Color fundus photograph, 1659 x 2212 pixels, captured on a Remidio Fundus on Phone (FOP) camera.
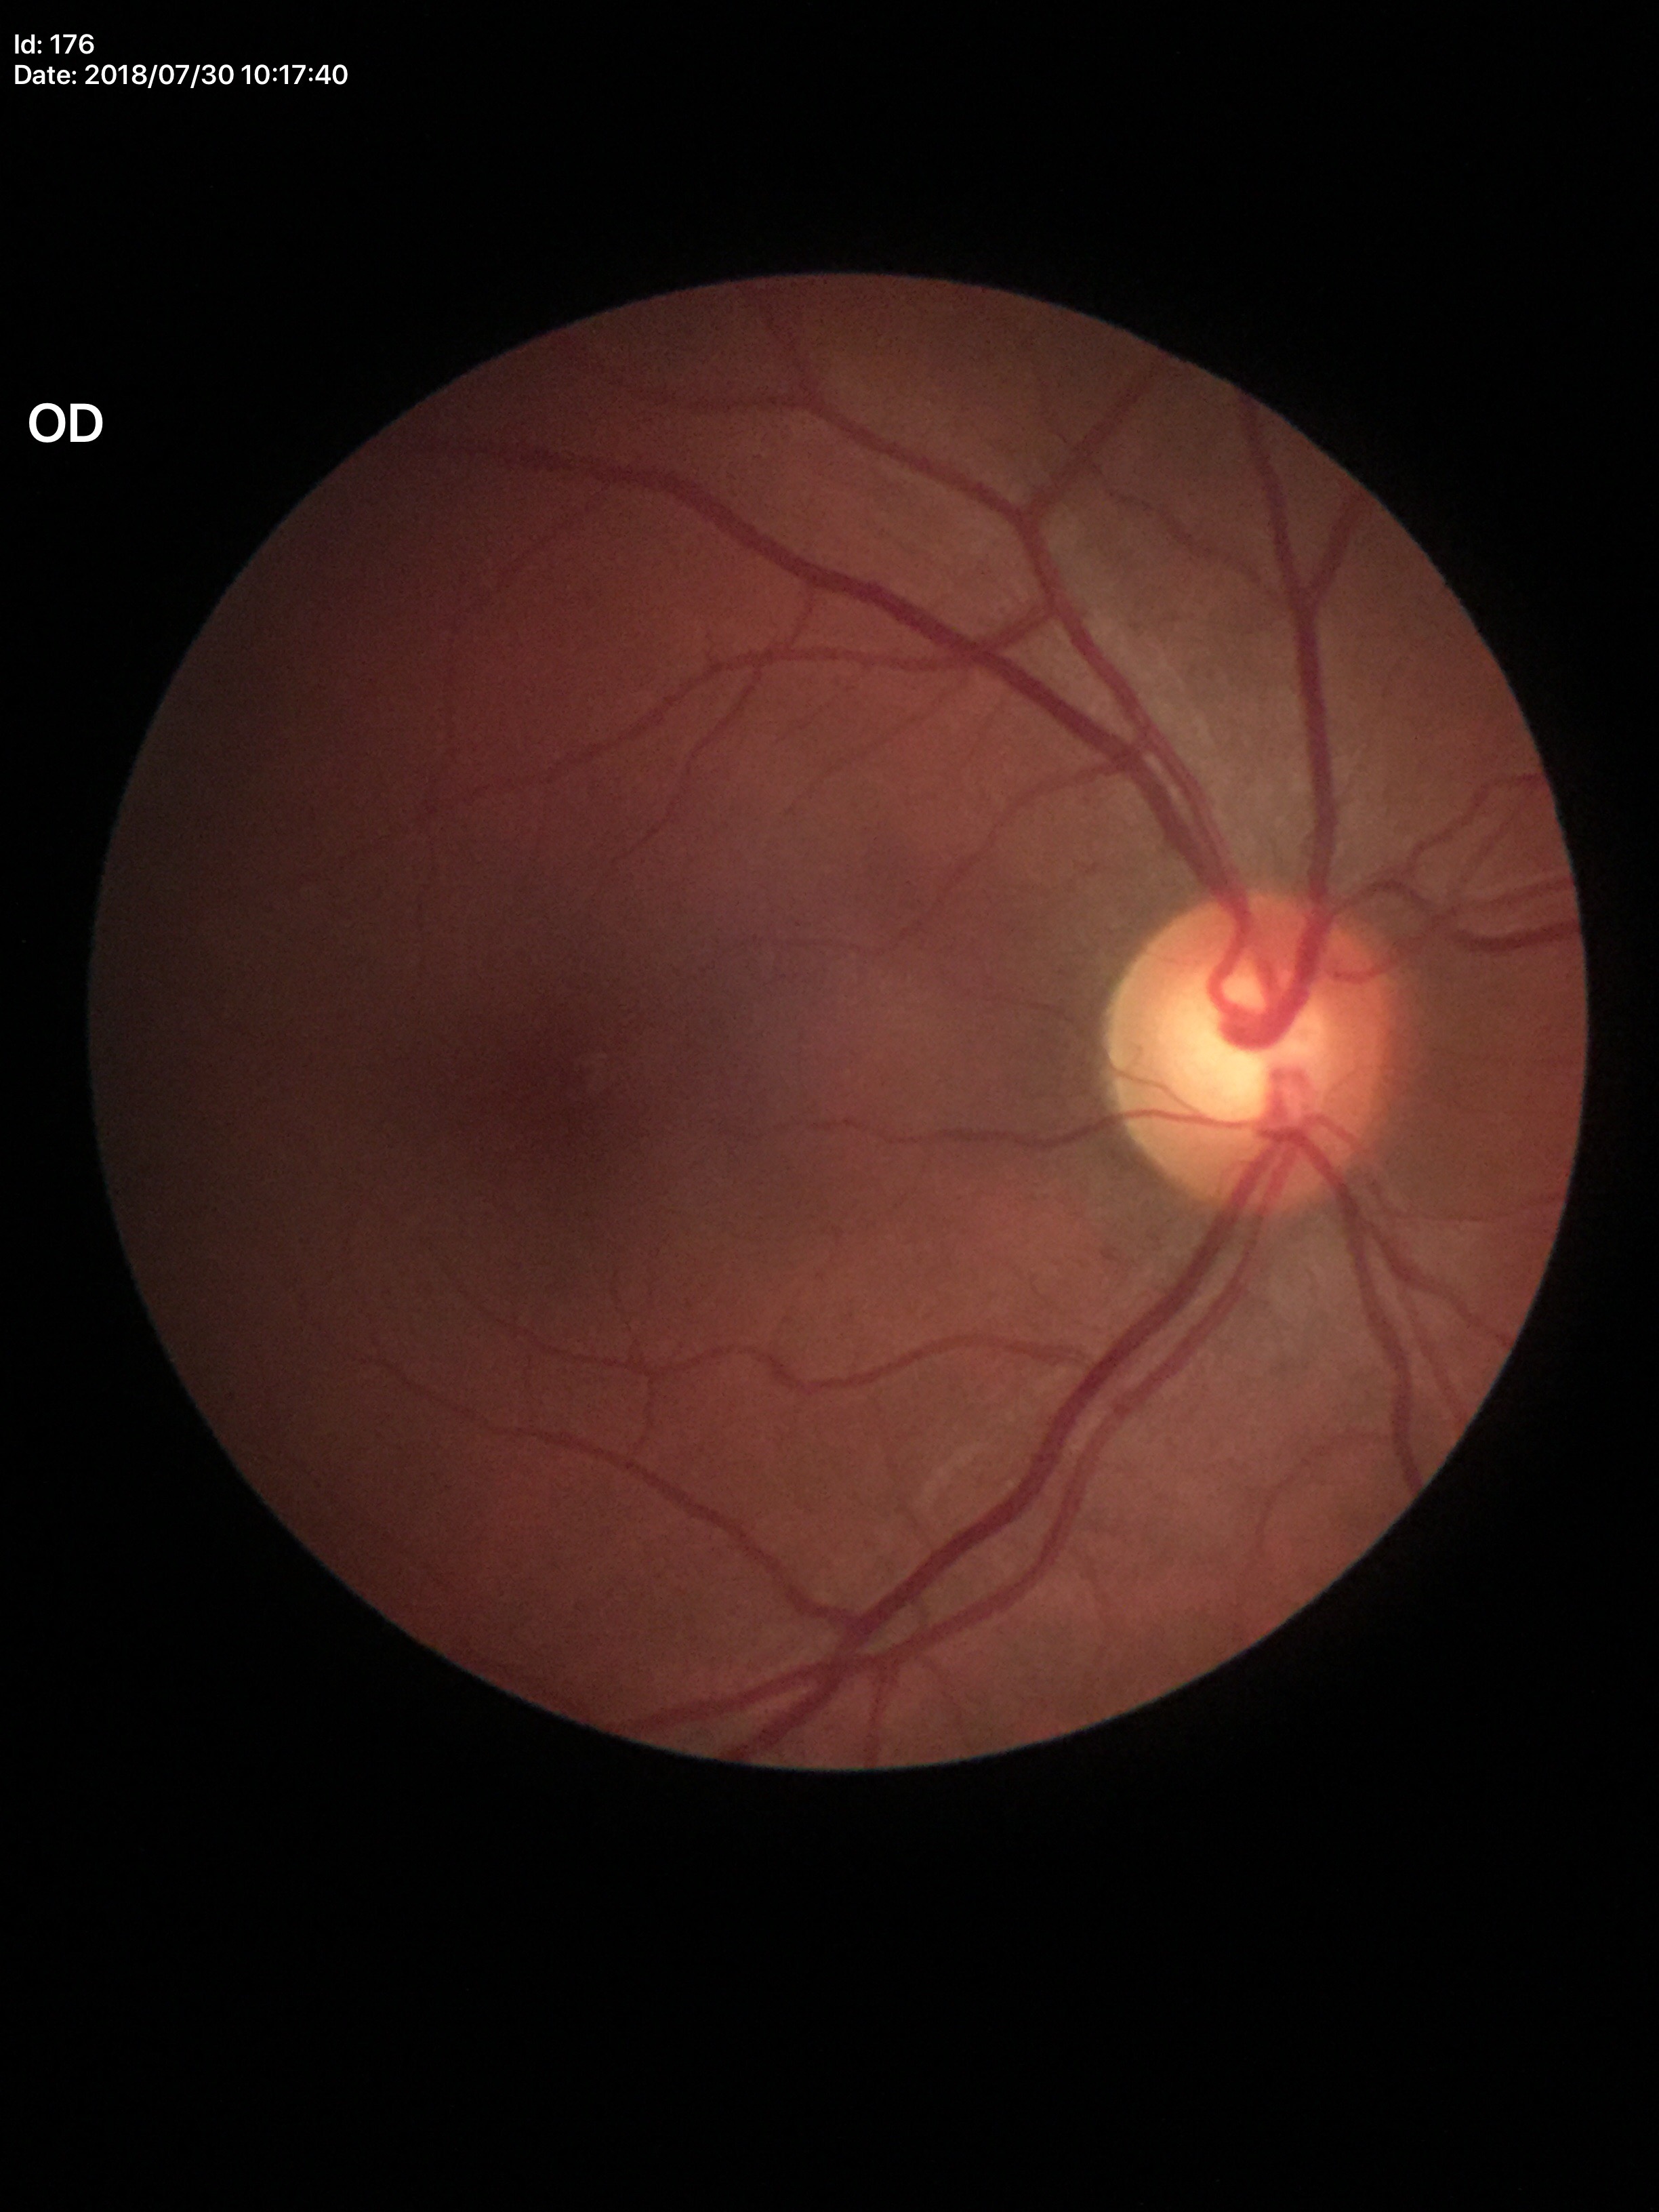

vertical cup-to-disc ratio: 0.58; Glaucoma screening: not suspect.